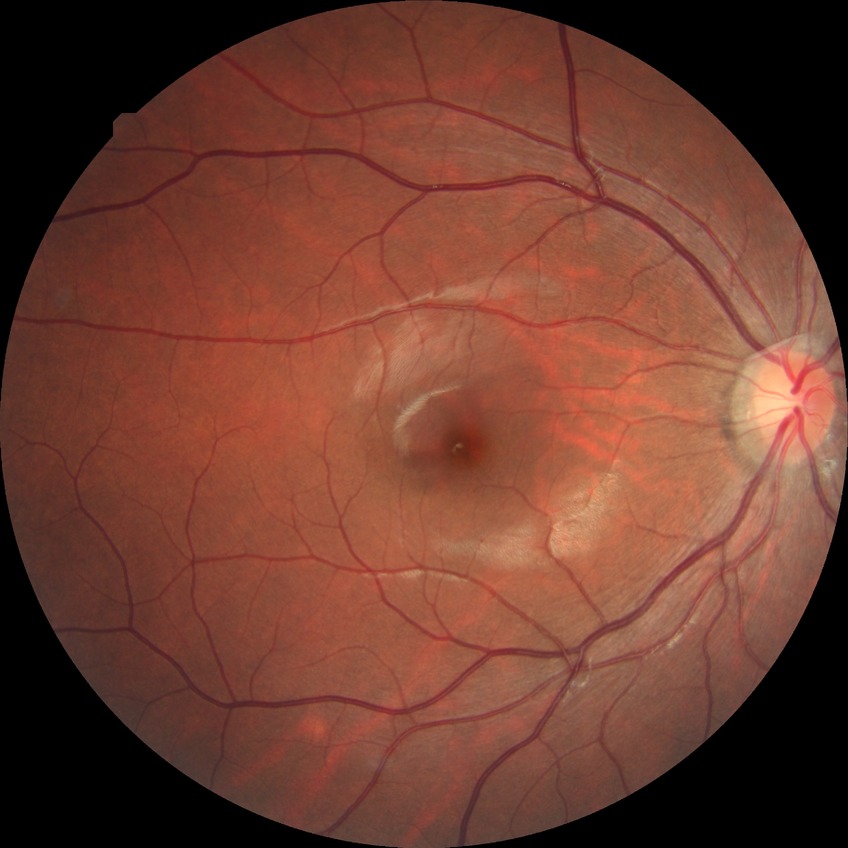 DR impression@no DR findings, modified Davis grade@NDR.